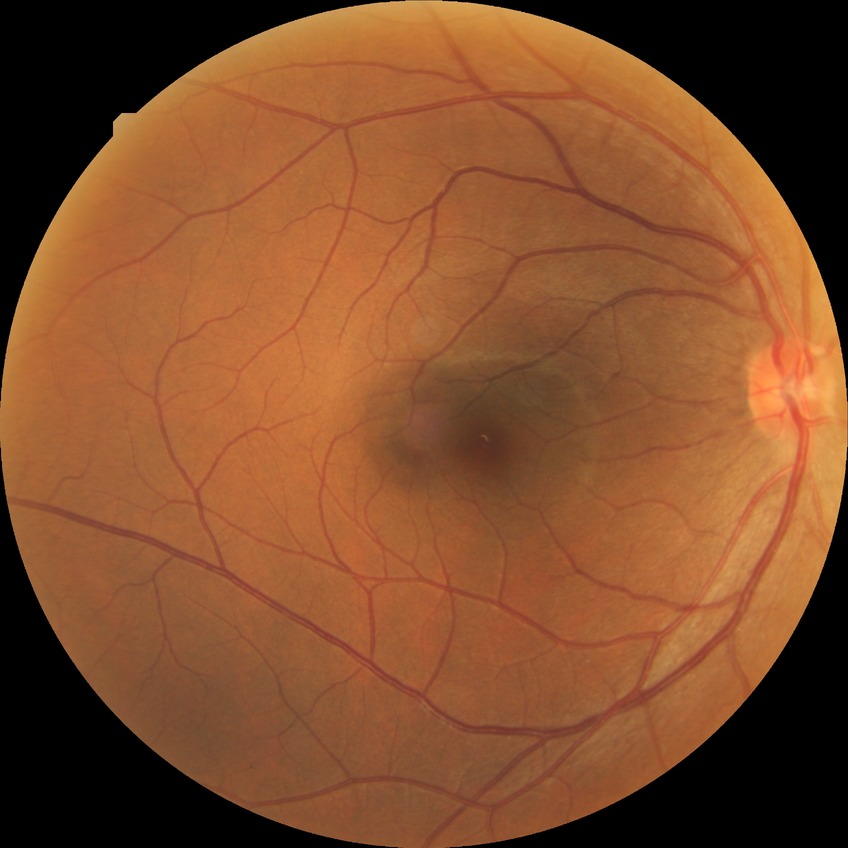

Diabetic retinopathy (DR): SDR (simple diabetic retinopathy). The retinopathy is classified as non-proliferative diabetic retinopathy.